NIDEK AFC-230 · posterior pole color fundus photograph · diabetic retinopathy graded by the modified Davis classification.
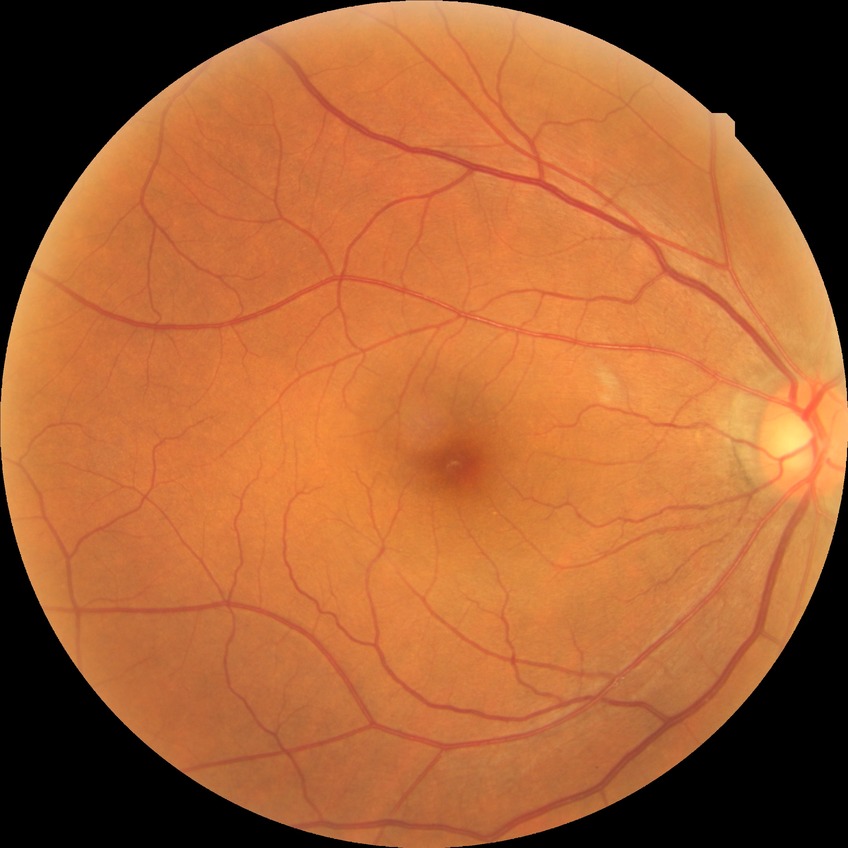 Retinopathy stage: no diabetic retinopathy.